Retinal fundus photograph.
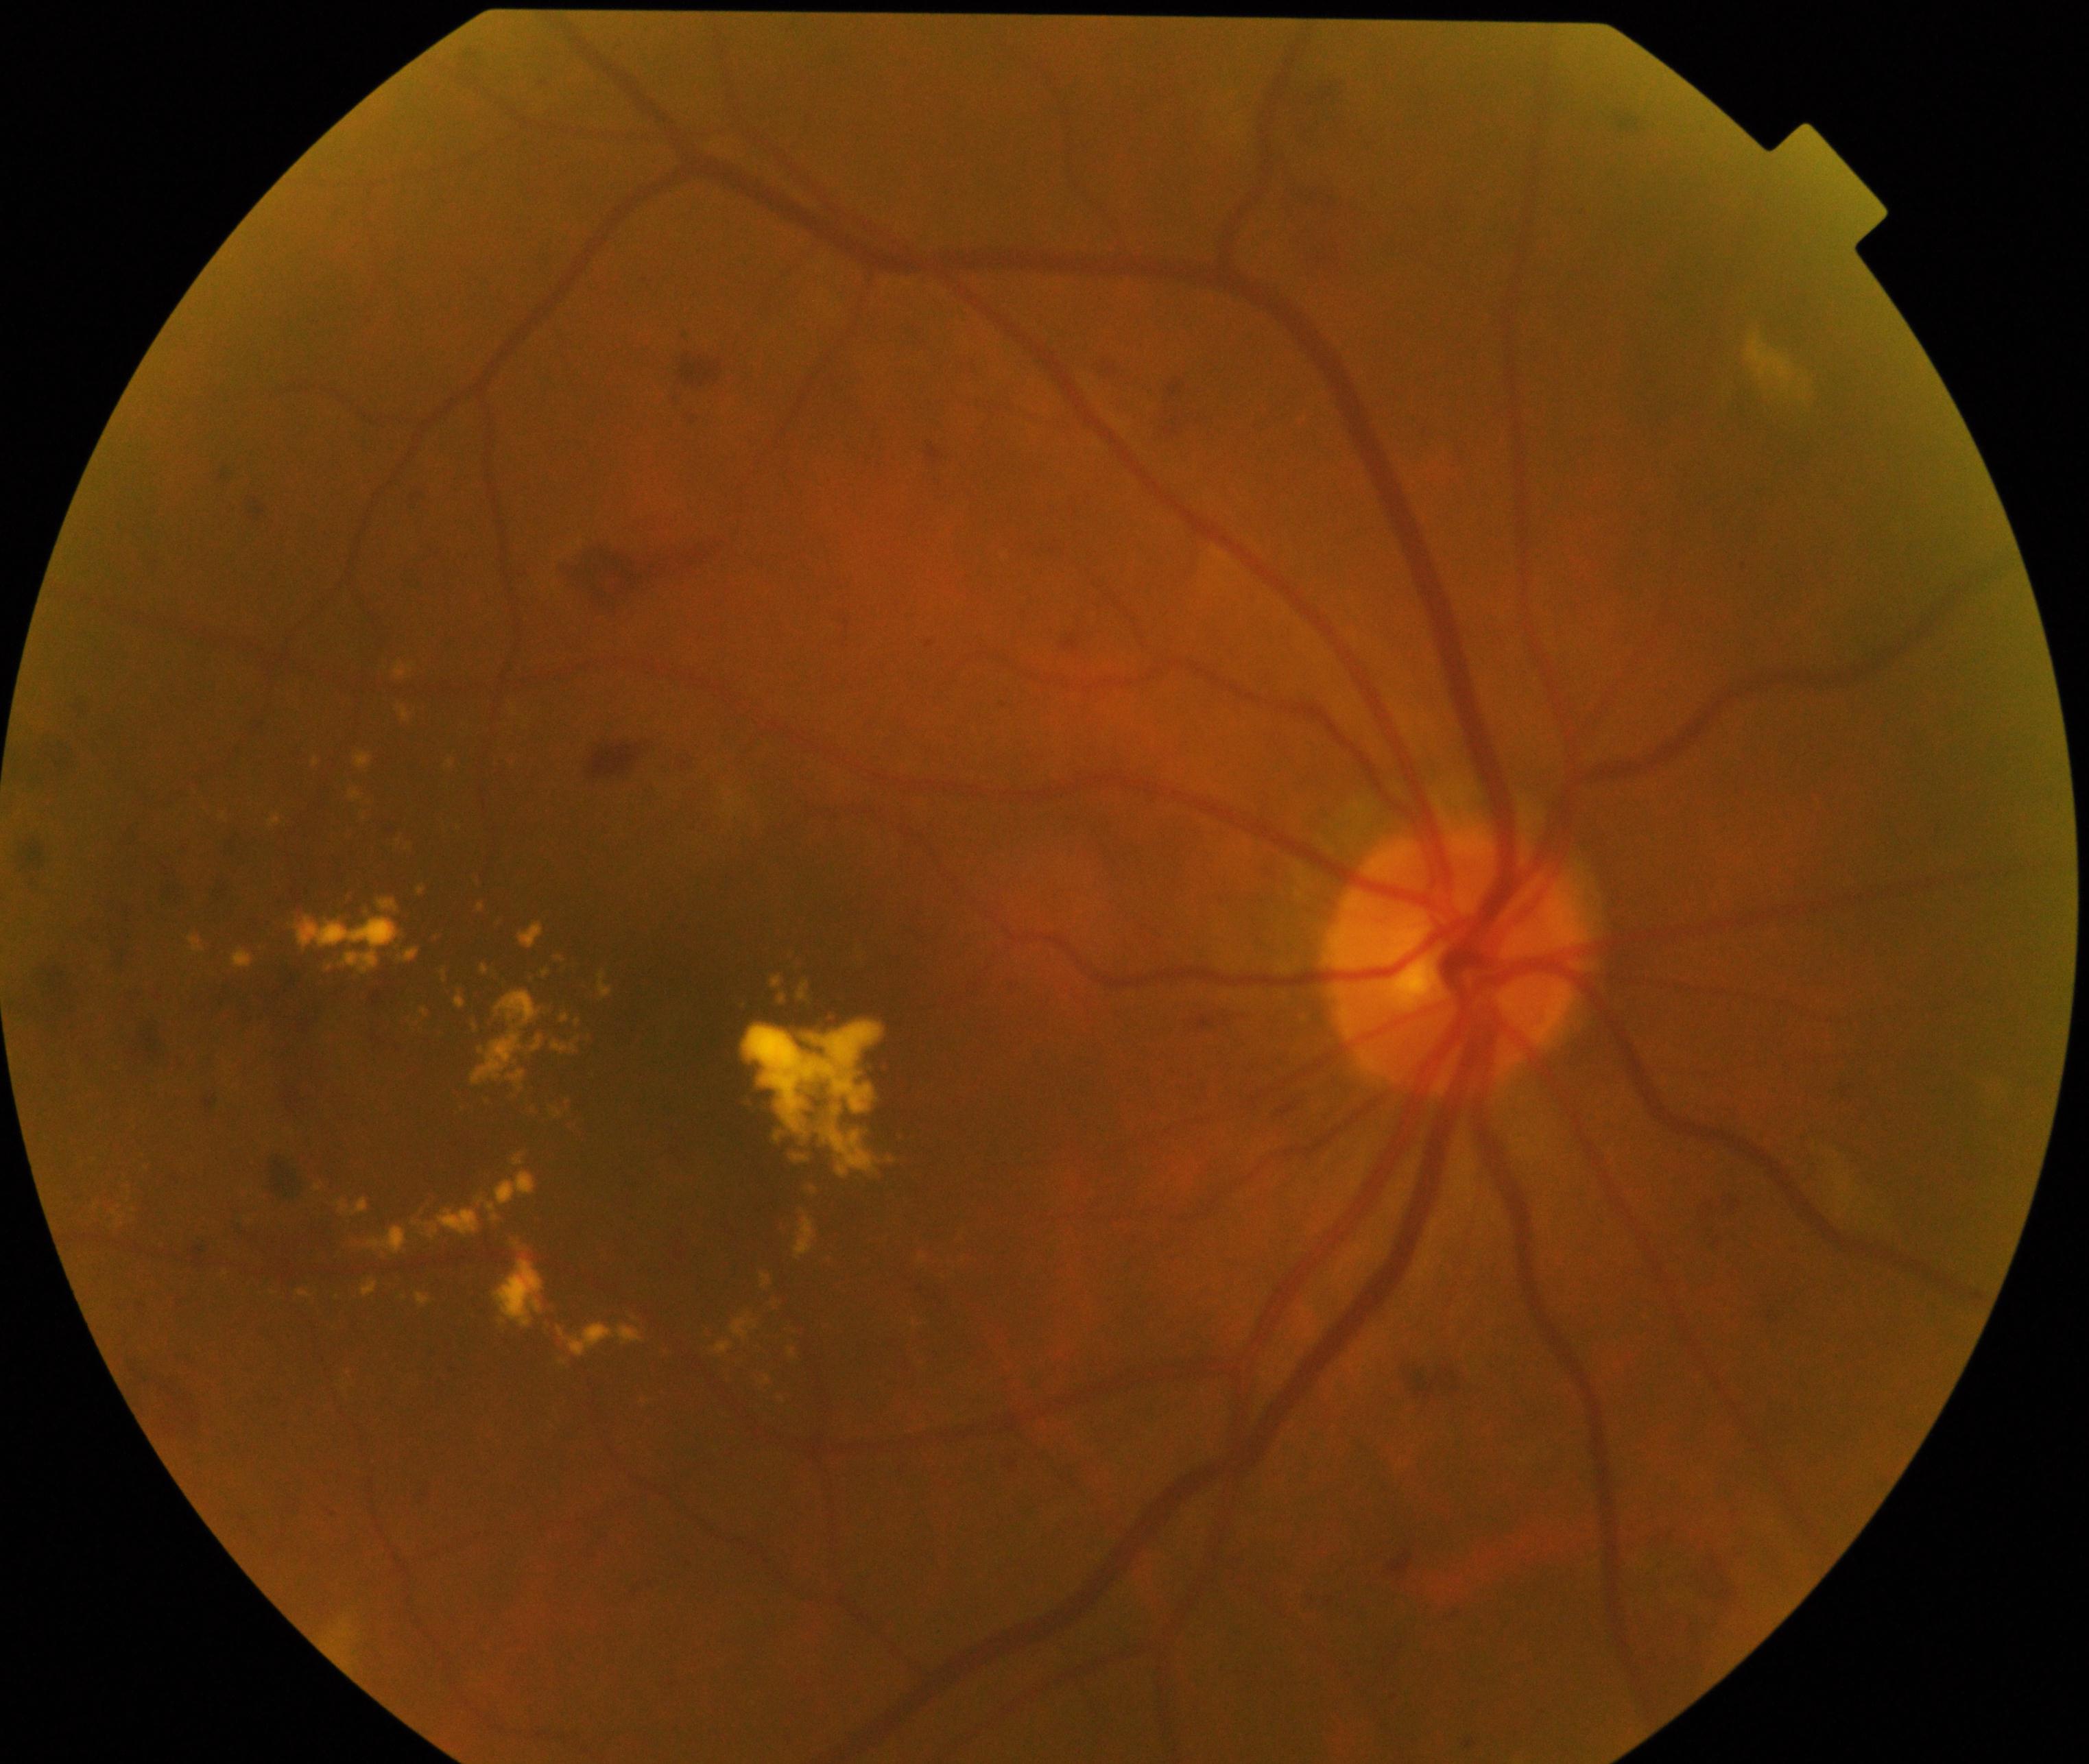
Diagnosis: moderate non-proliferative diabetic retinopathy.